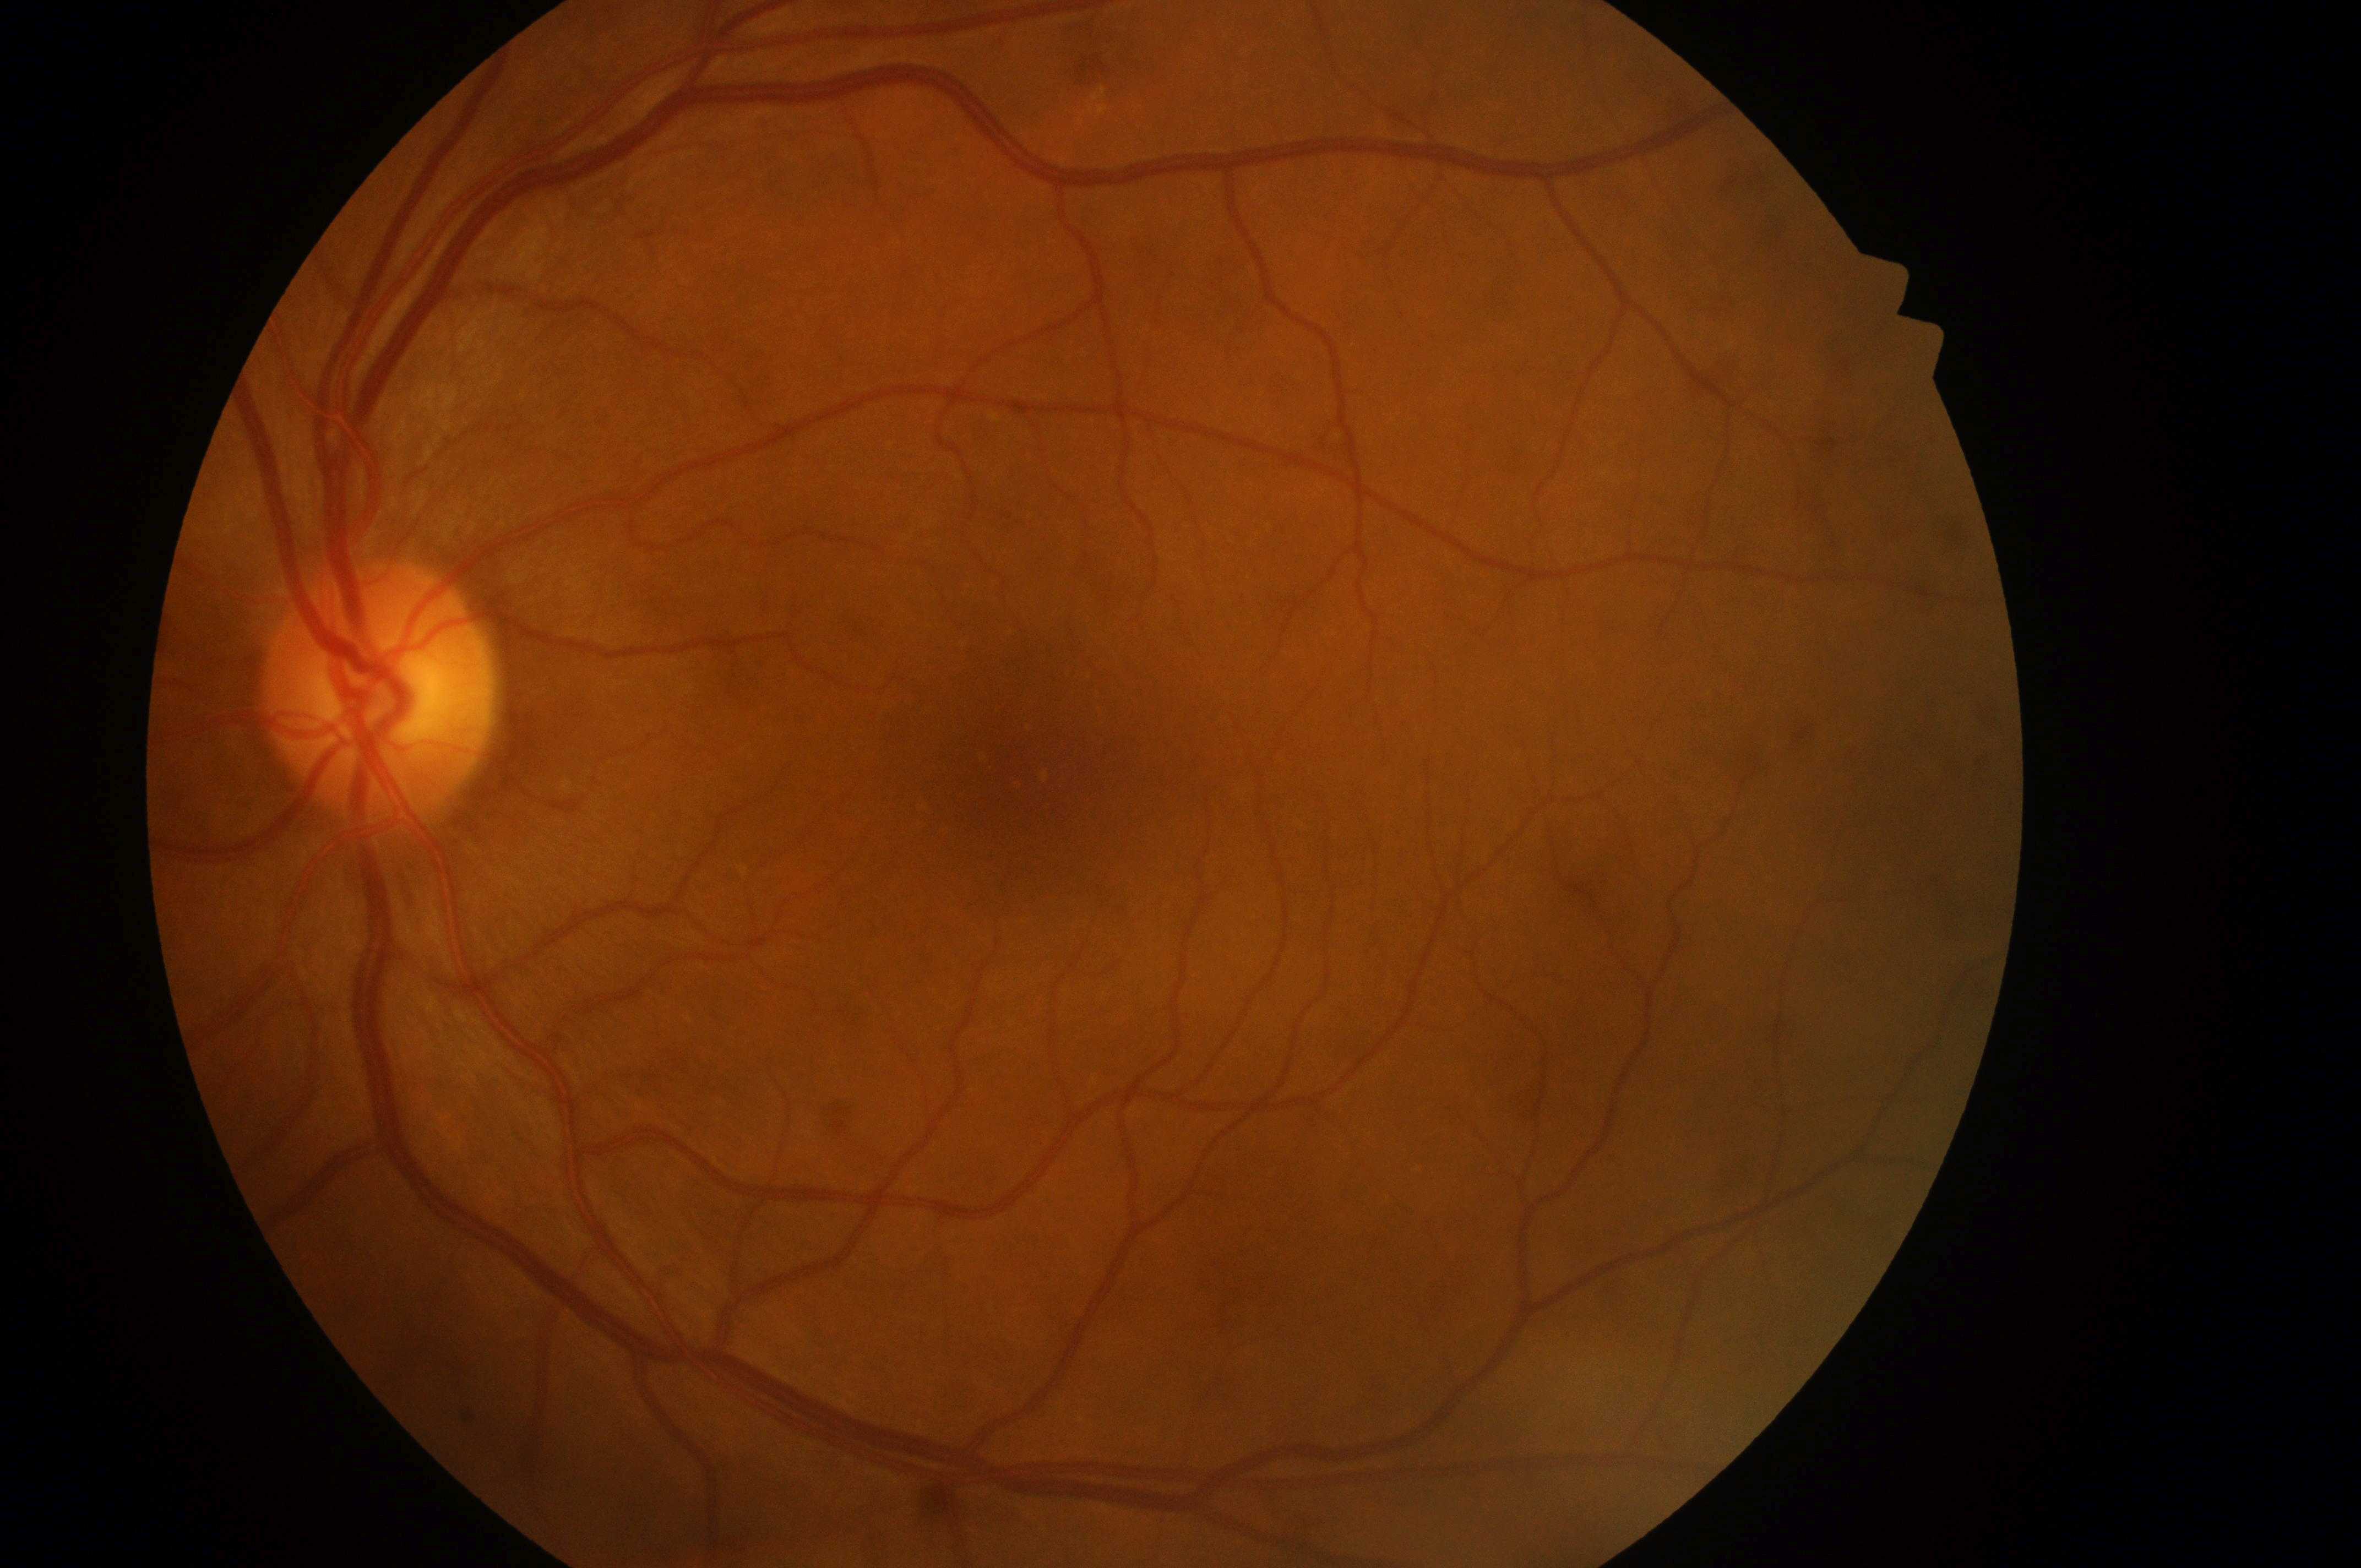
Findings:
• disc center — 375, 701
• macula center — 1027, 777
• risk of macular edema — grade 0 (no risk)
• diabetic retinopathy — no apparent diabetic retinopathy (grade 0)
• eye — OS